Nonmydriatic · 848 x 848 pixels — 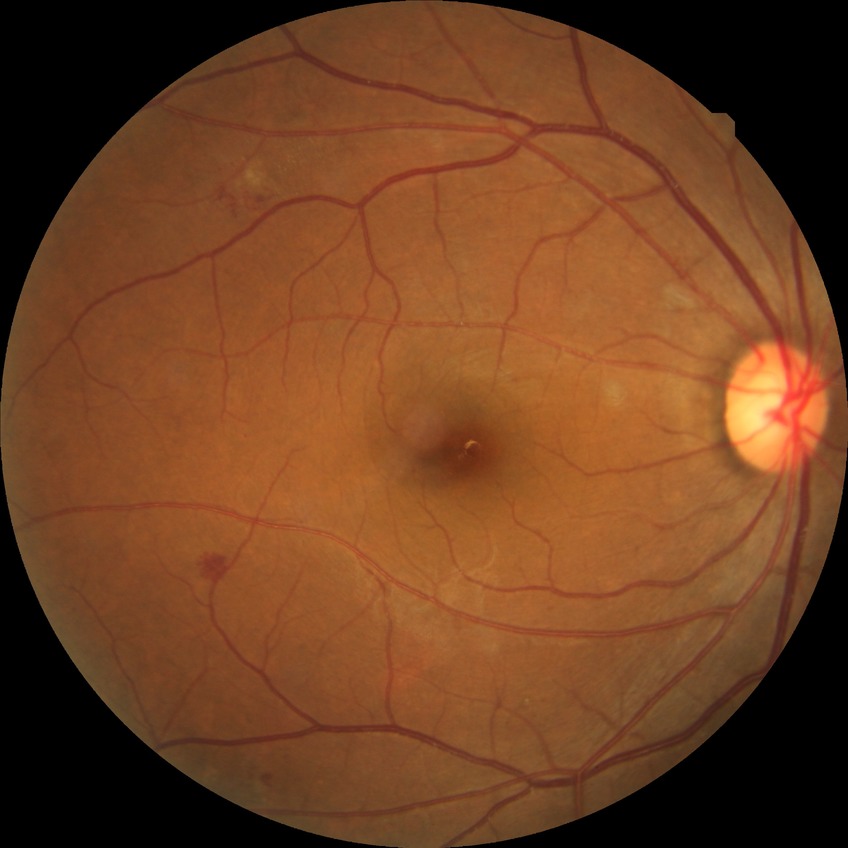

davis_grade: simple diabetic retinopathy